Color fundus photograph: 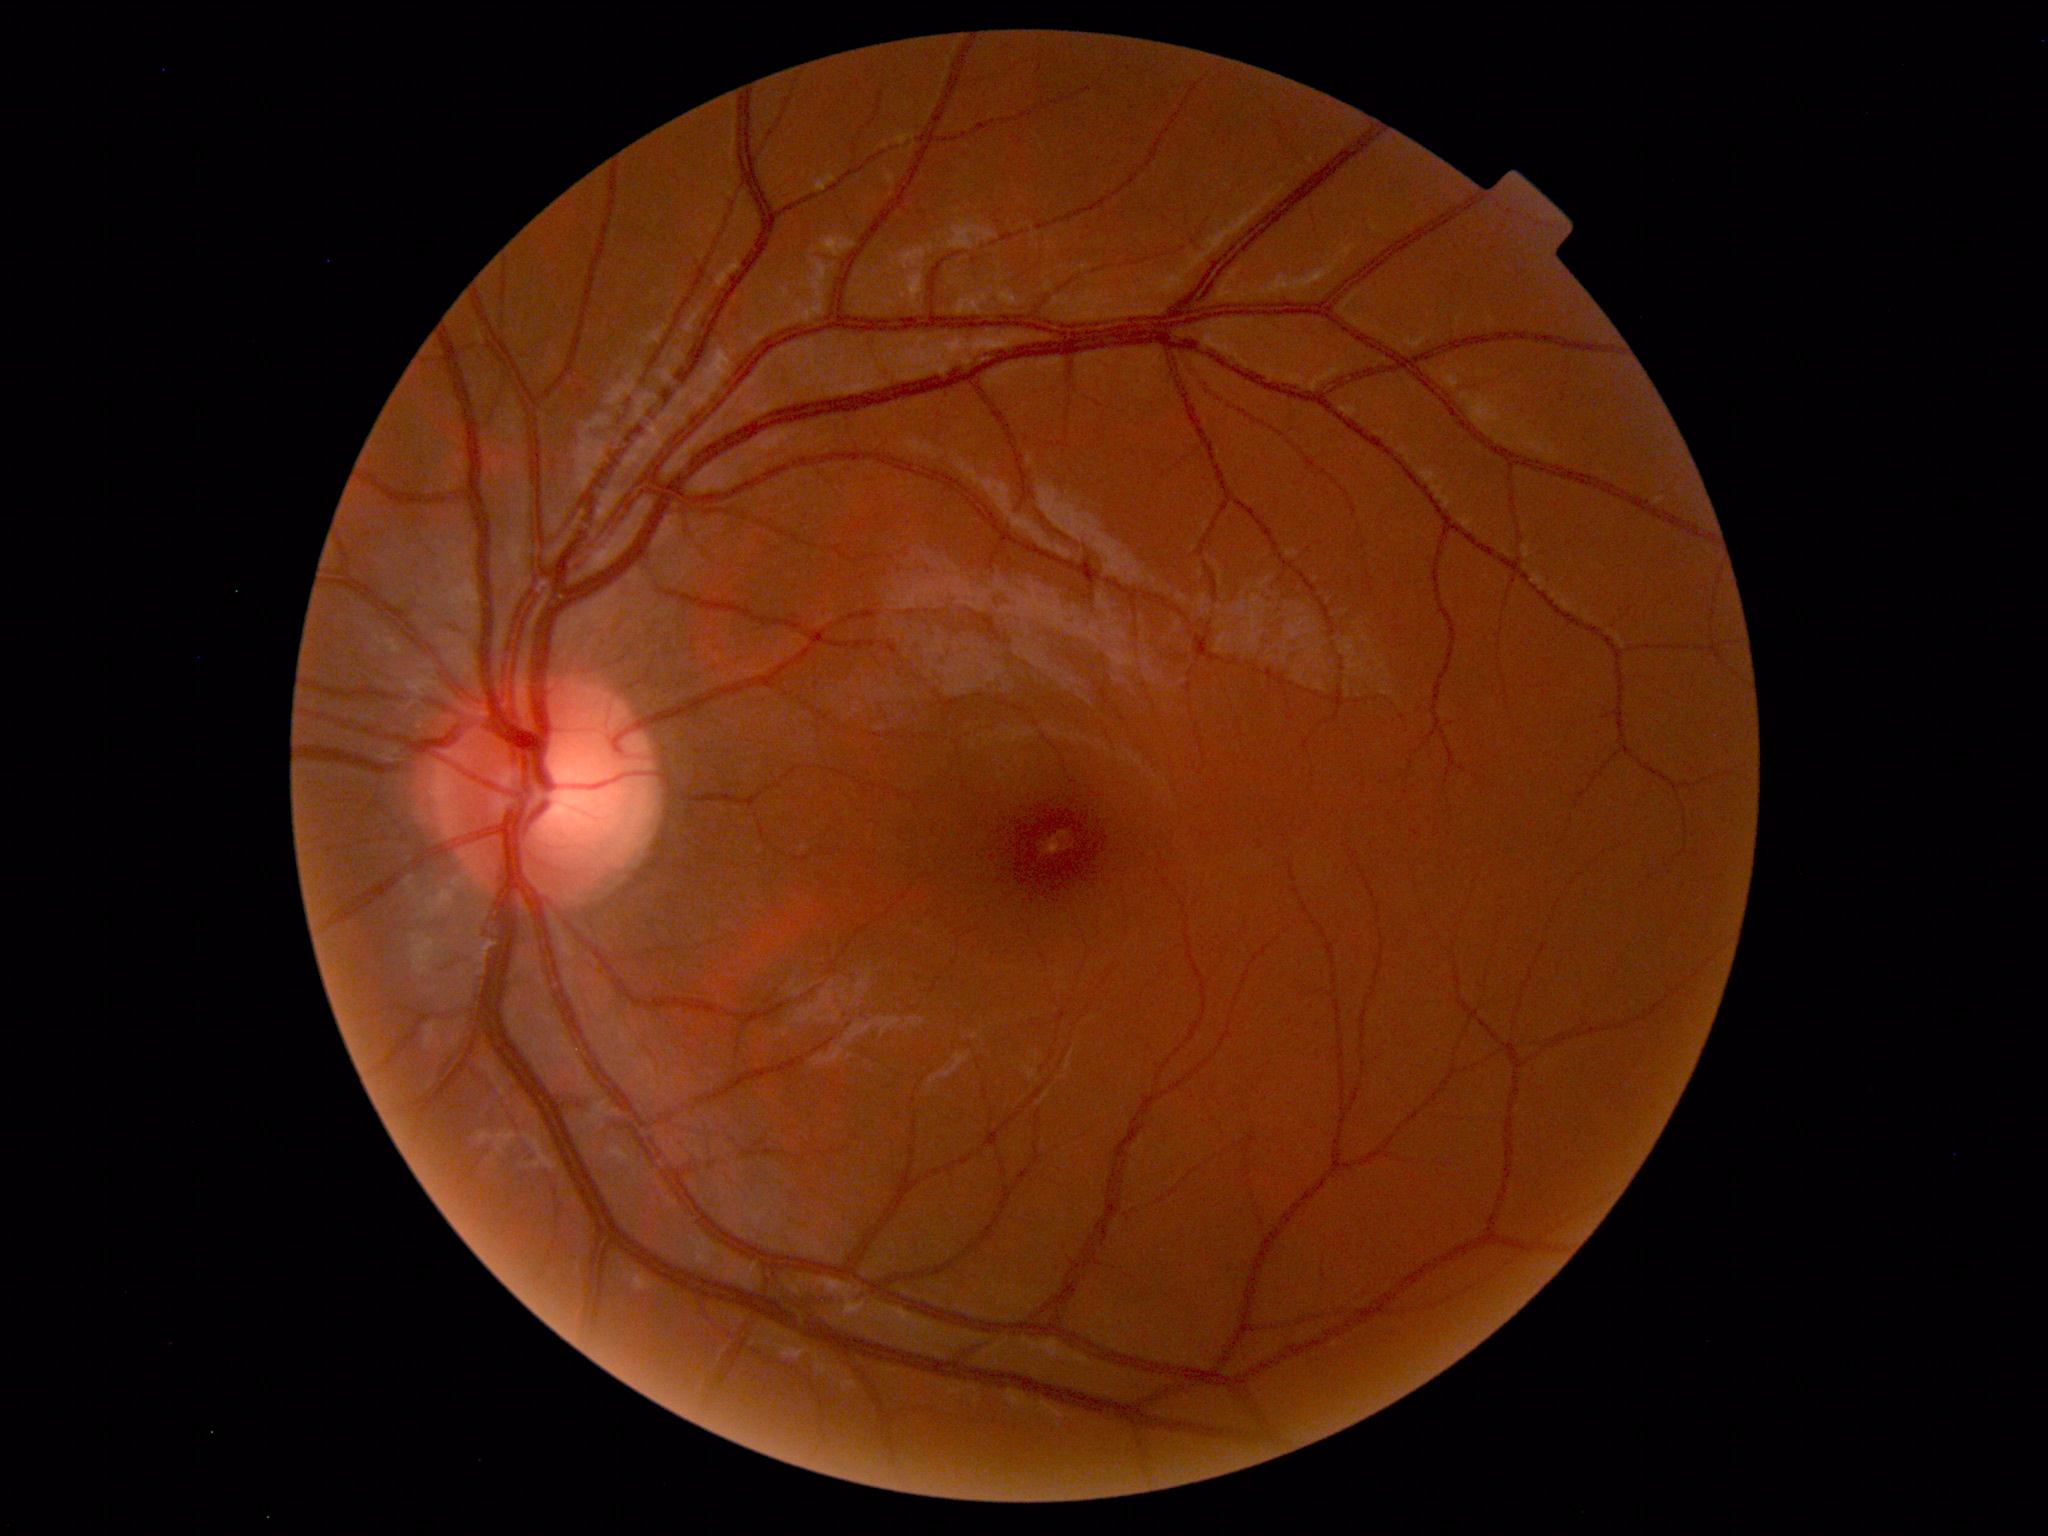 Normal fundus appearance.